Infant wide-field fundus photograph. 100° field of view (Phoenix ICON):
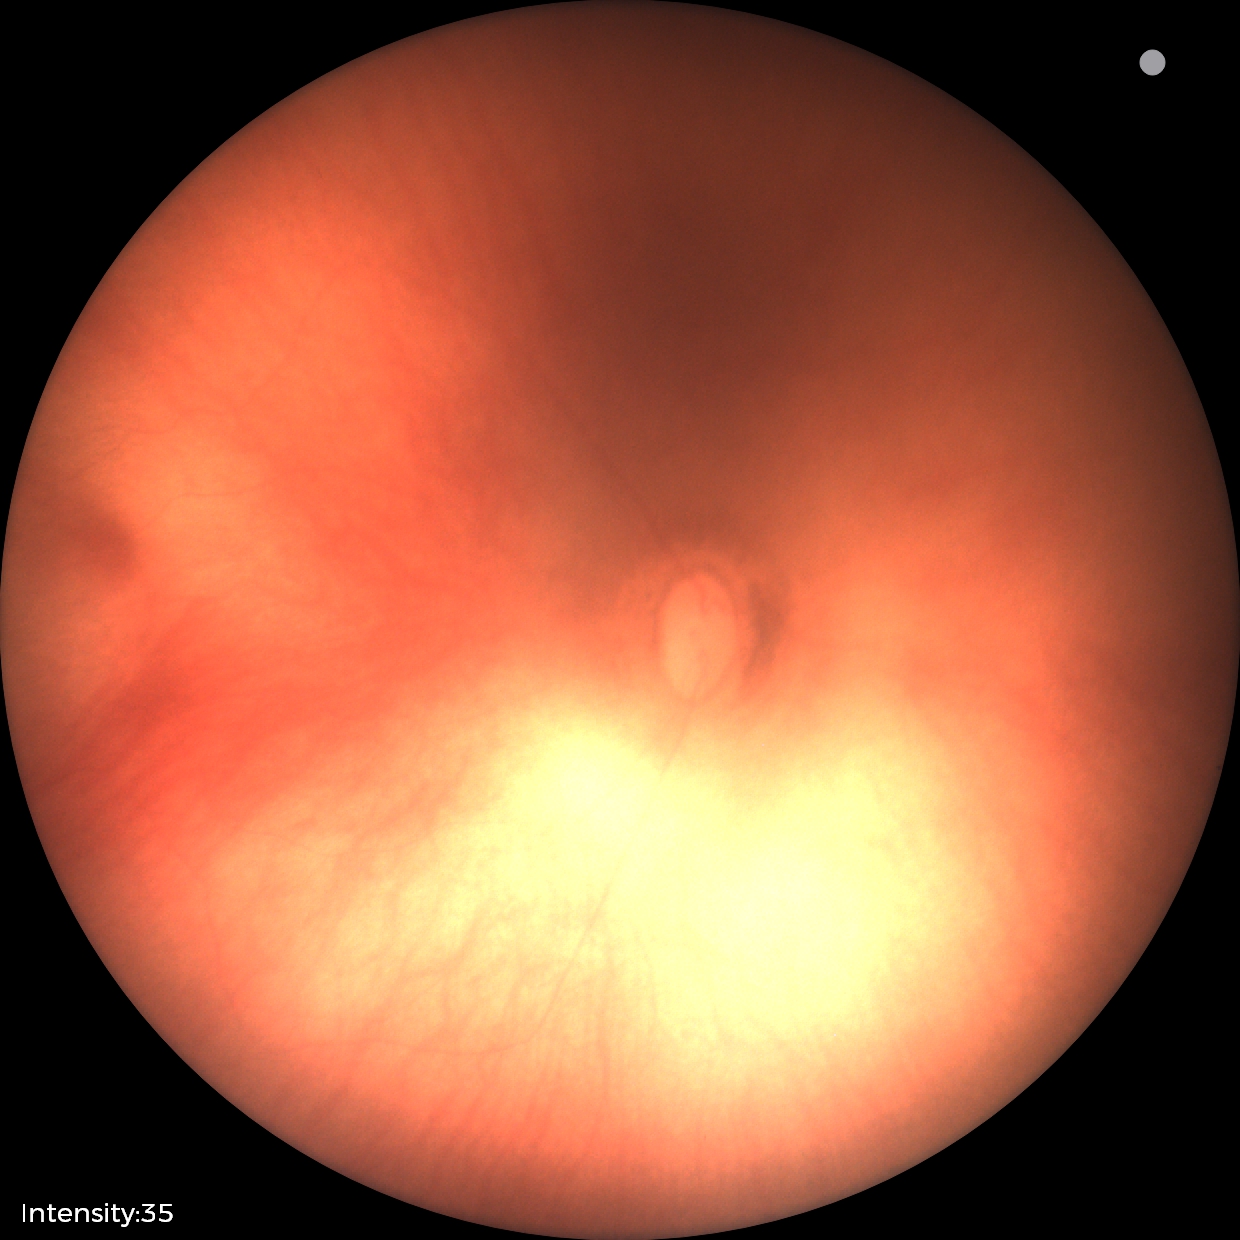

Assessment: physiological appearance.